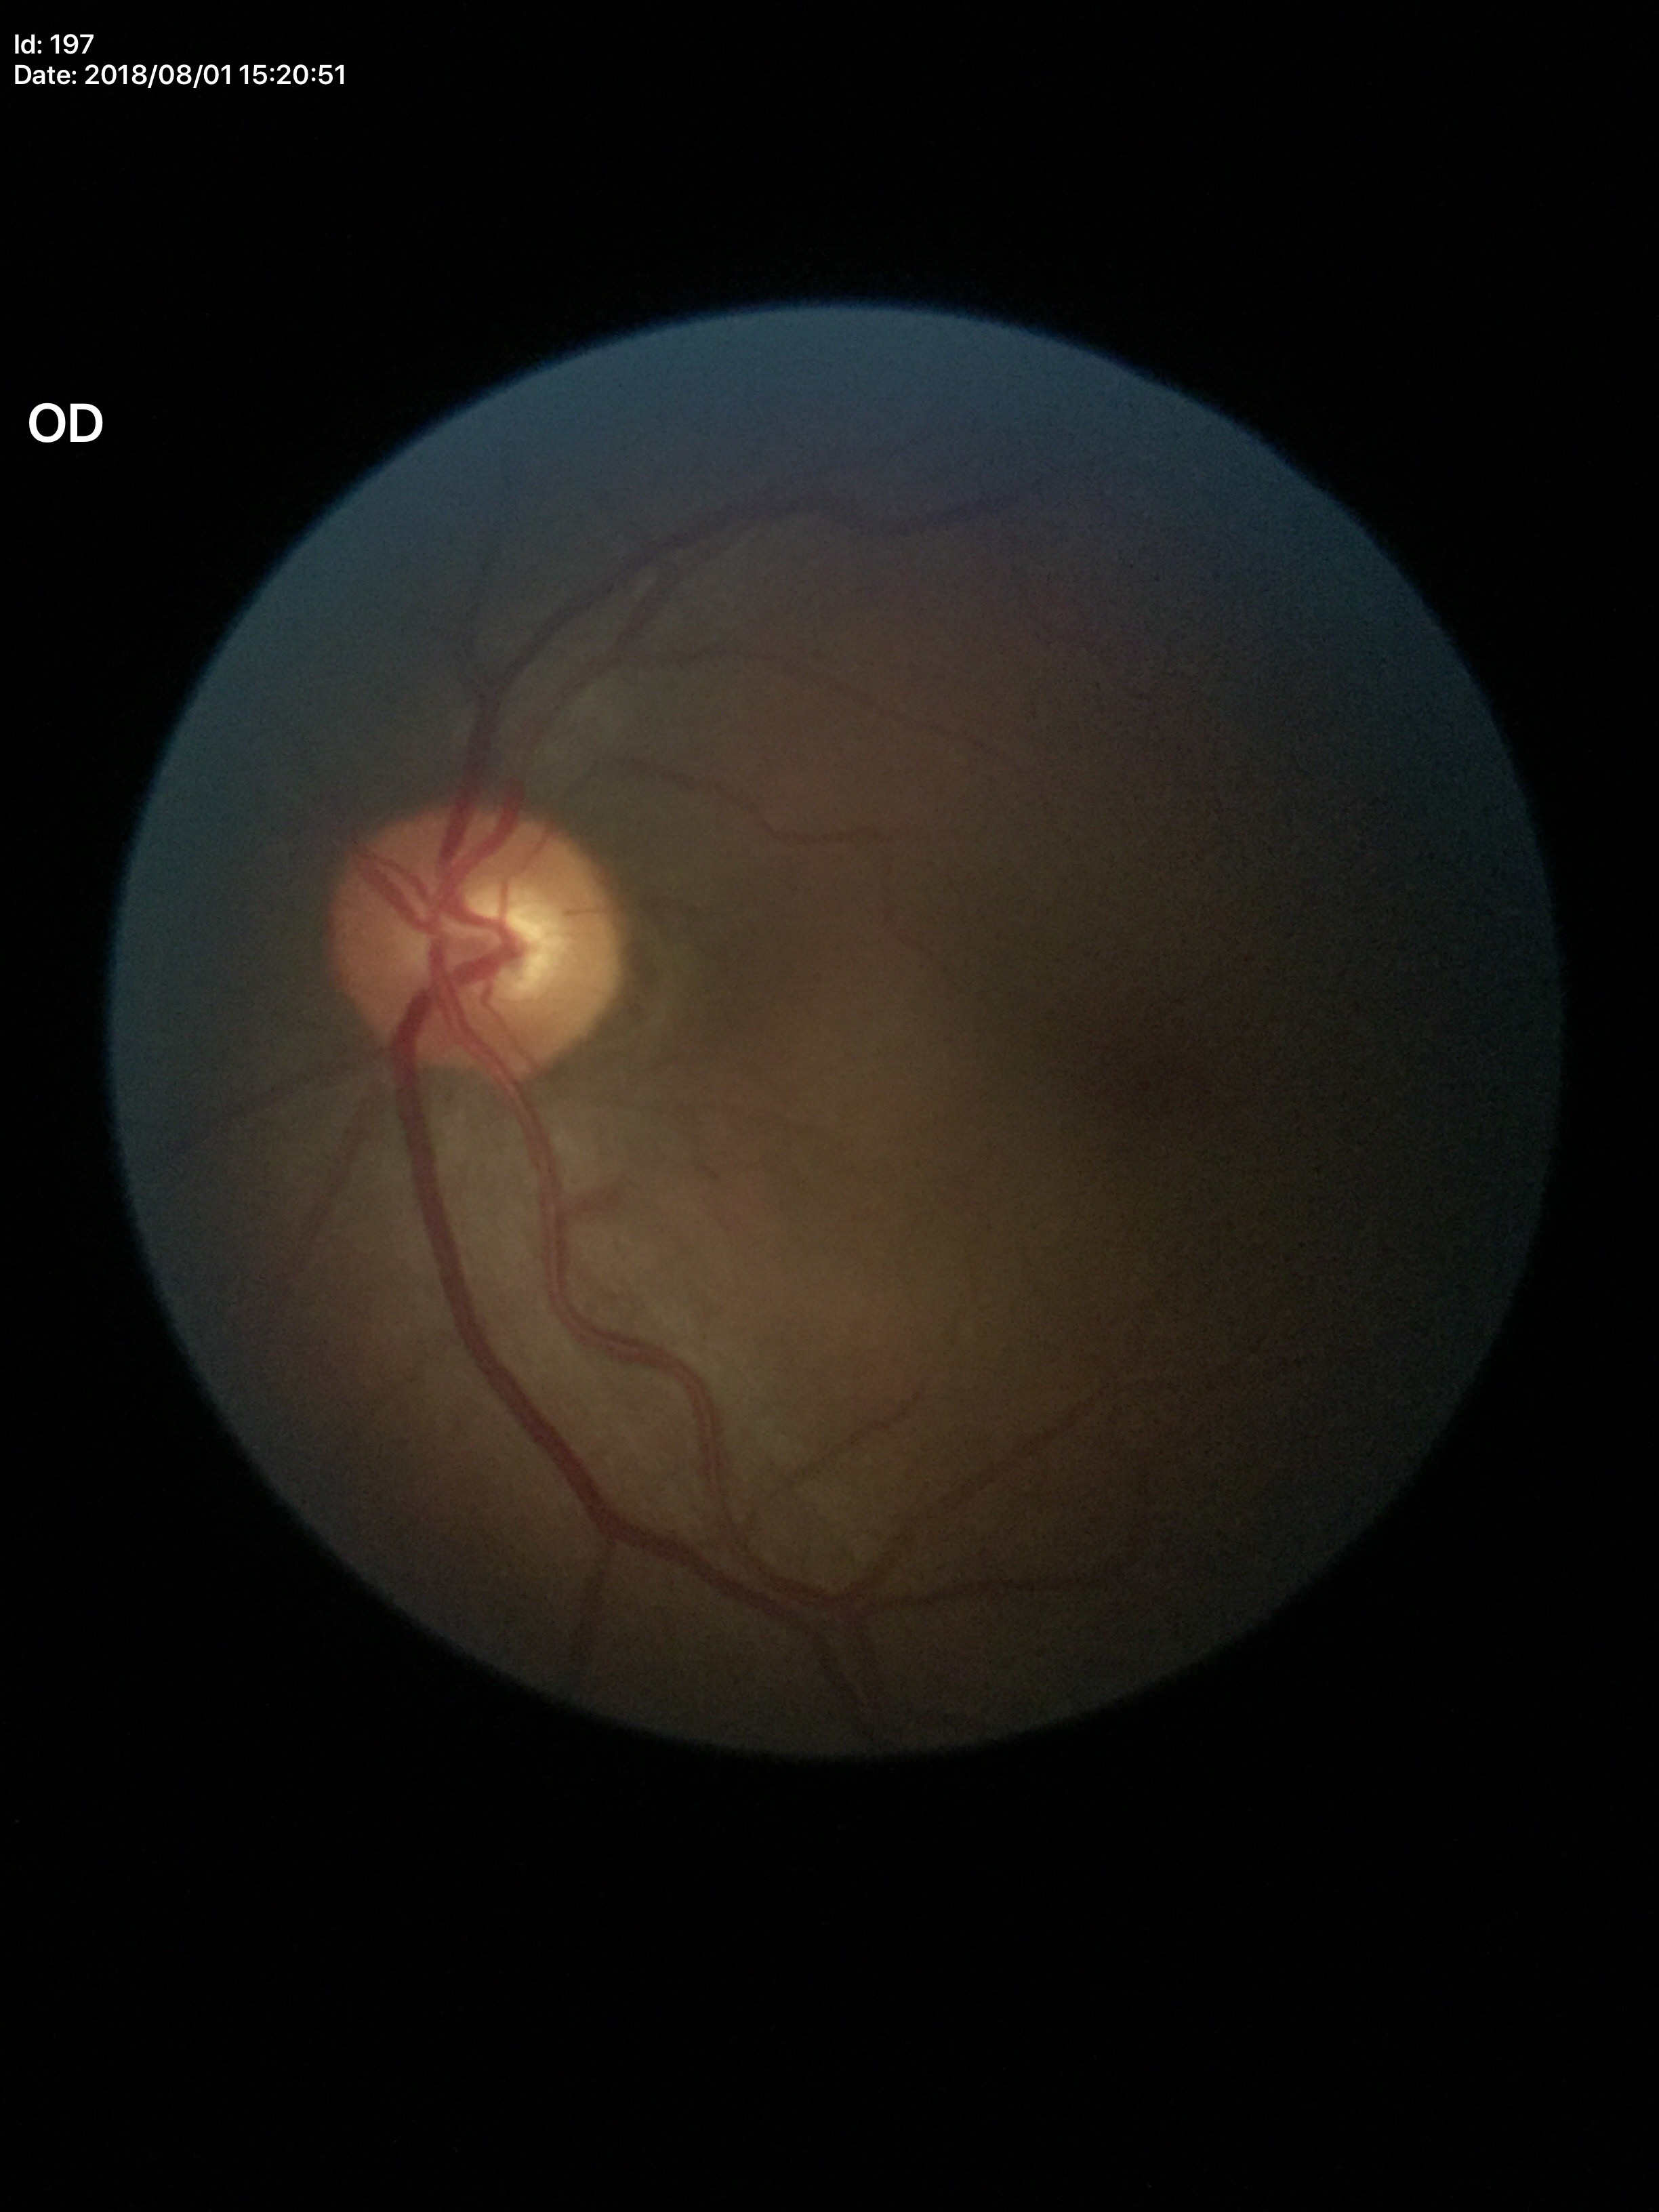
No glaucomatous findings. VCDR of 0.54. ACDR: 0.31. HCDR: 0.56.